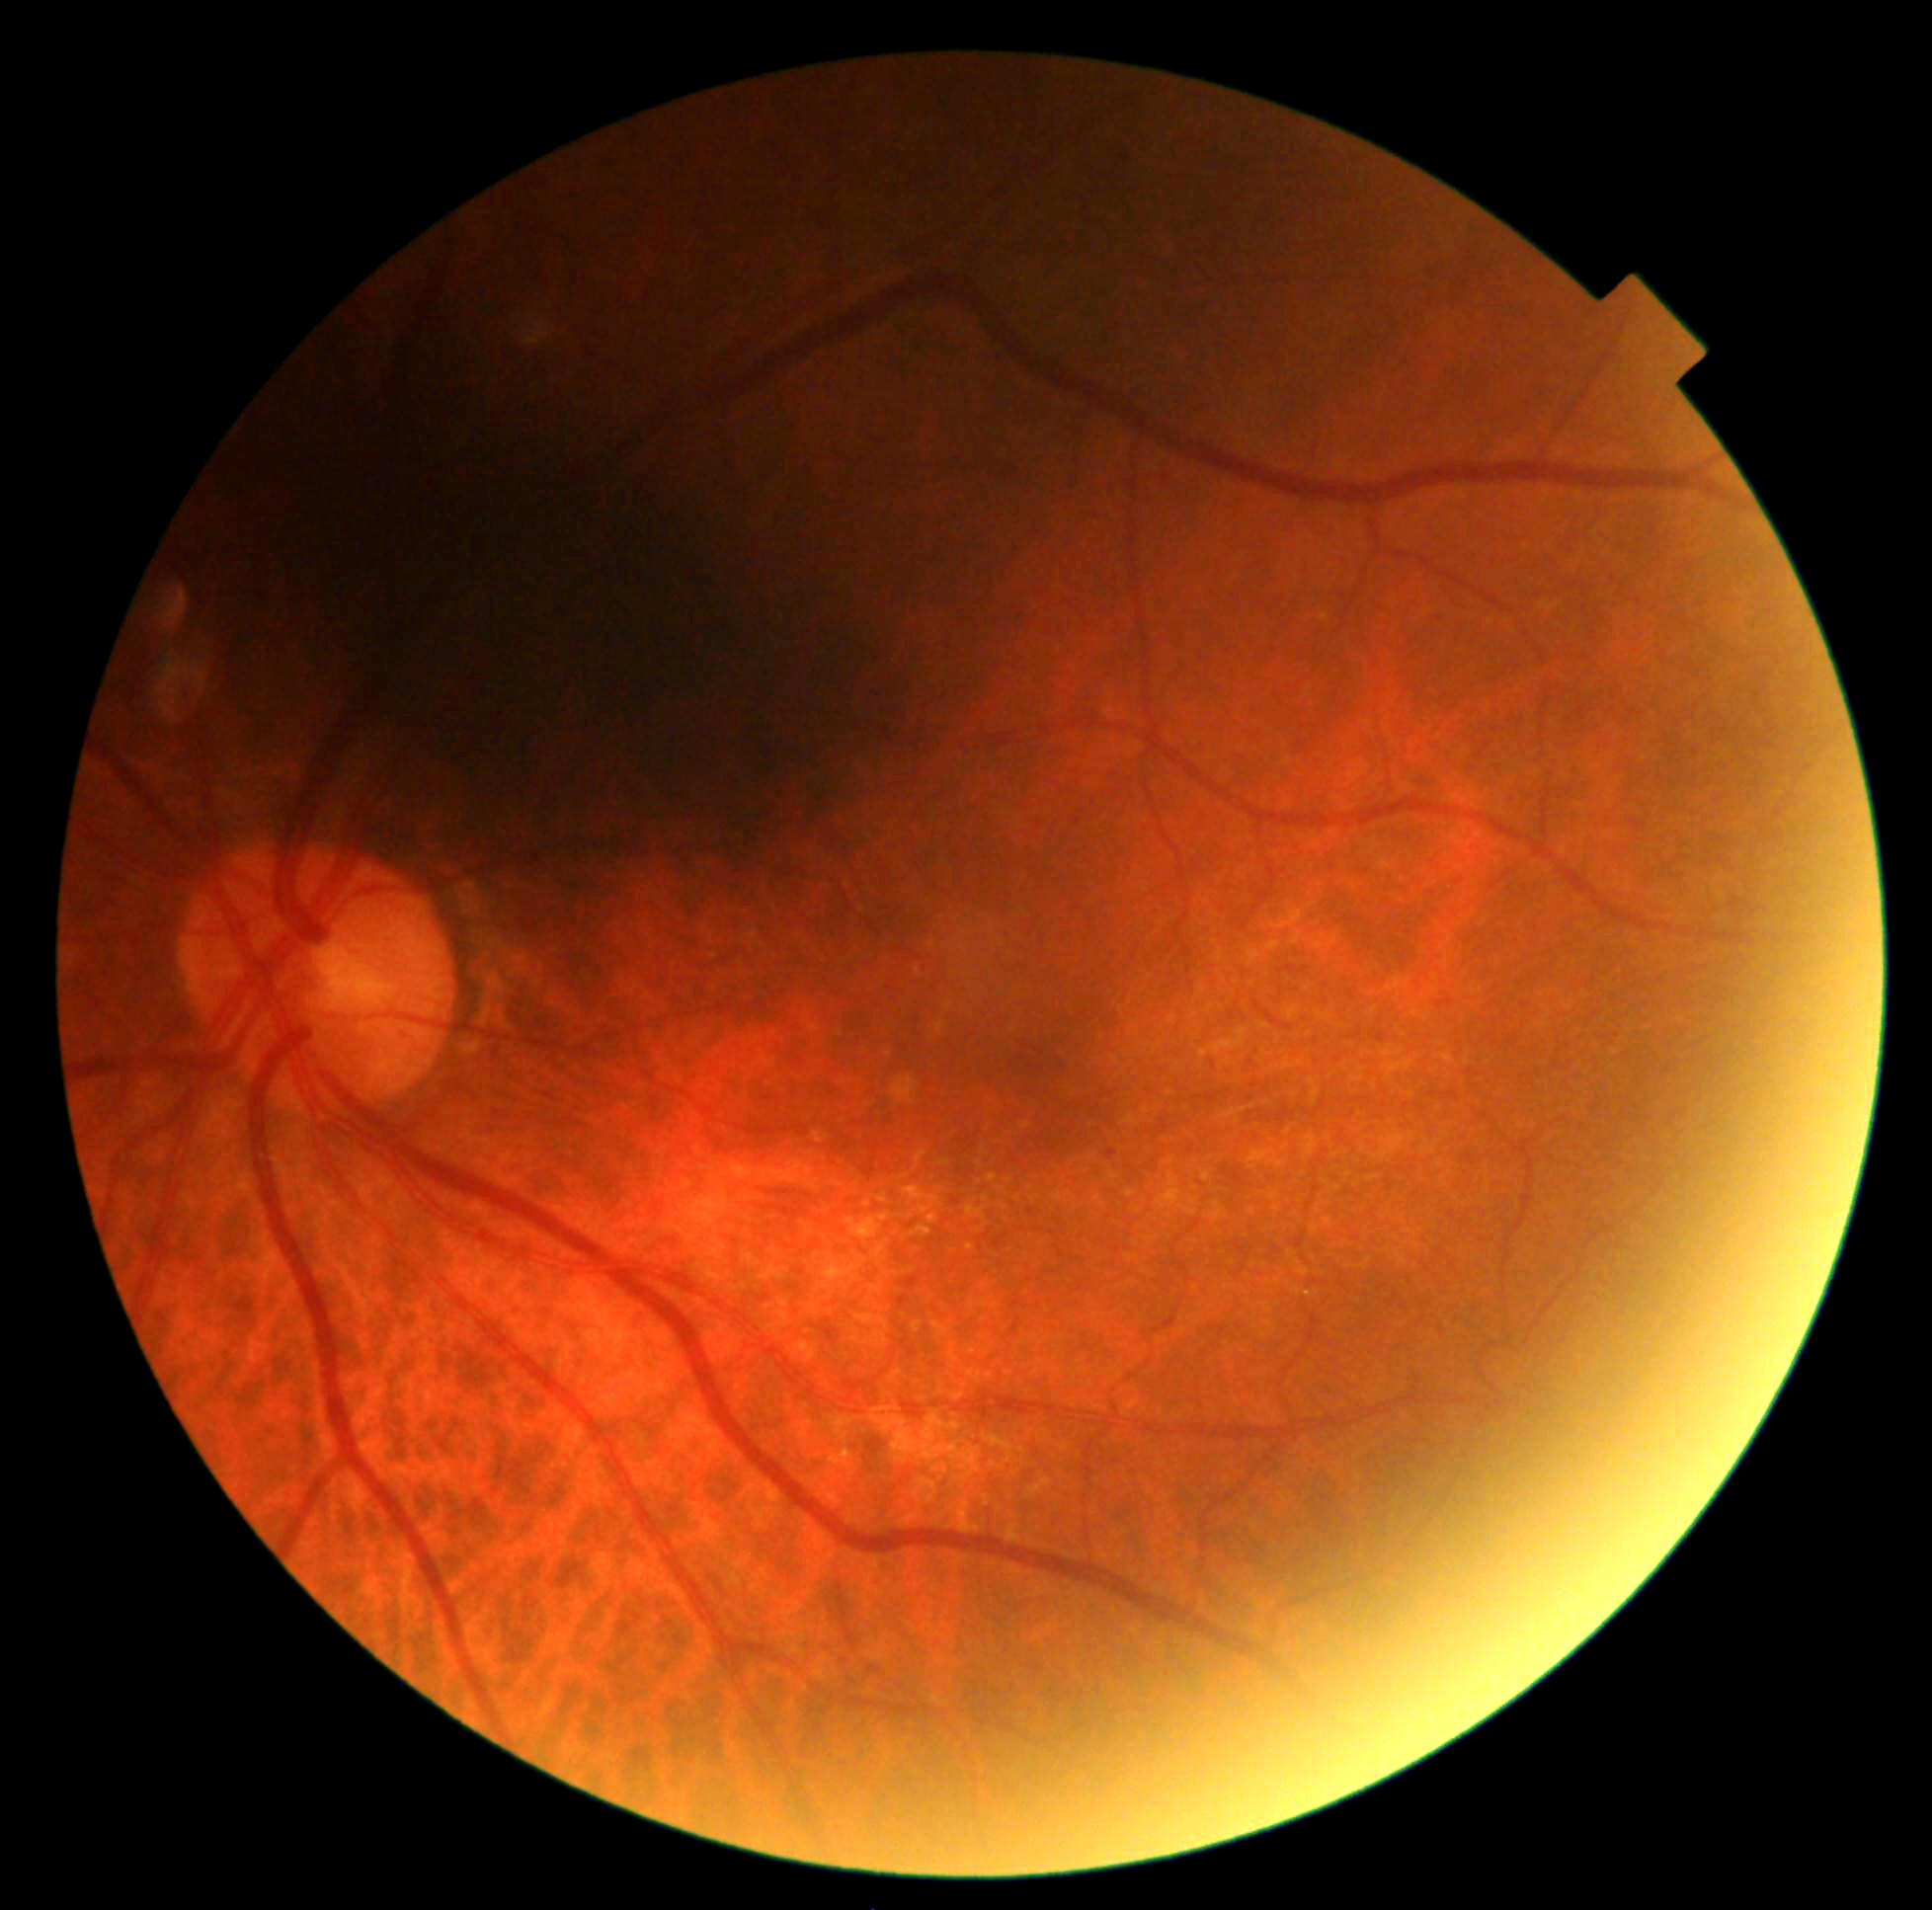

dr_grade: grade 1 (mild NPDR) — presence of microaneurysms only